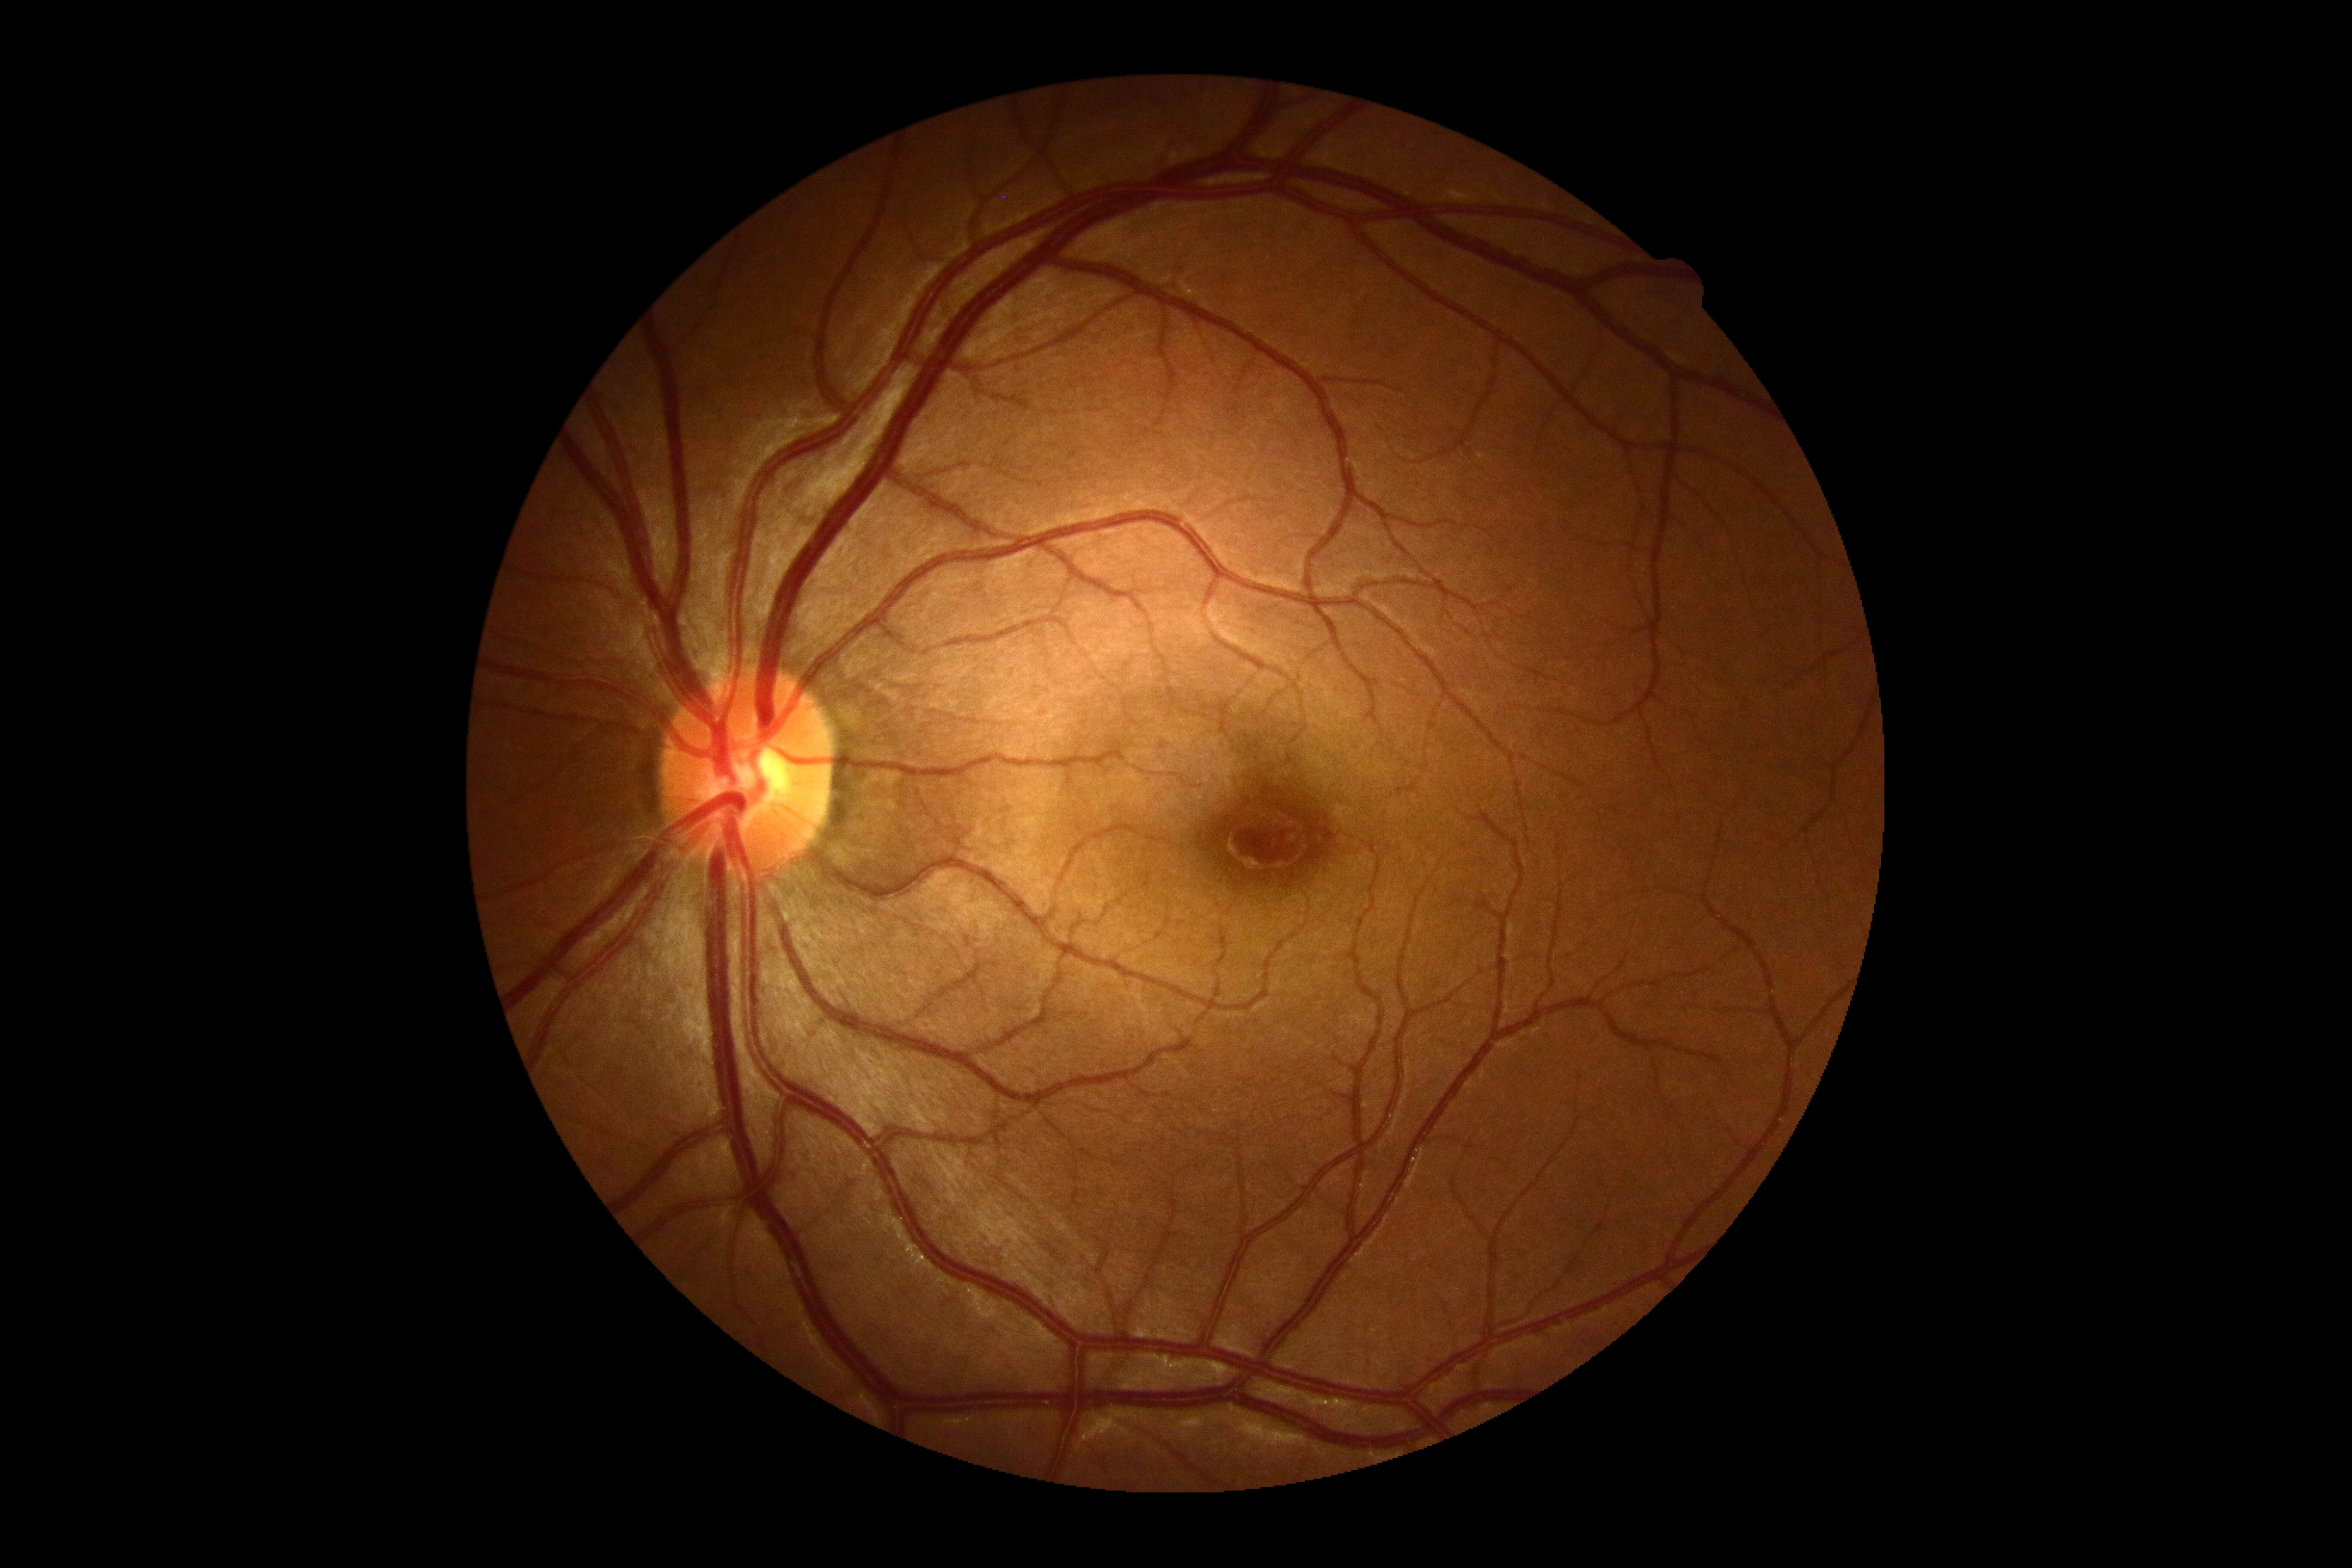 * diabetic retinopathy (DR) — grade 0 — no visible signs of diabetic retinopathy
* DR impression — no apparent DR